Color fundus image
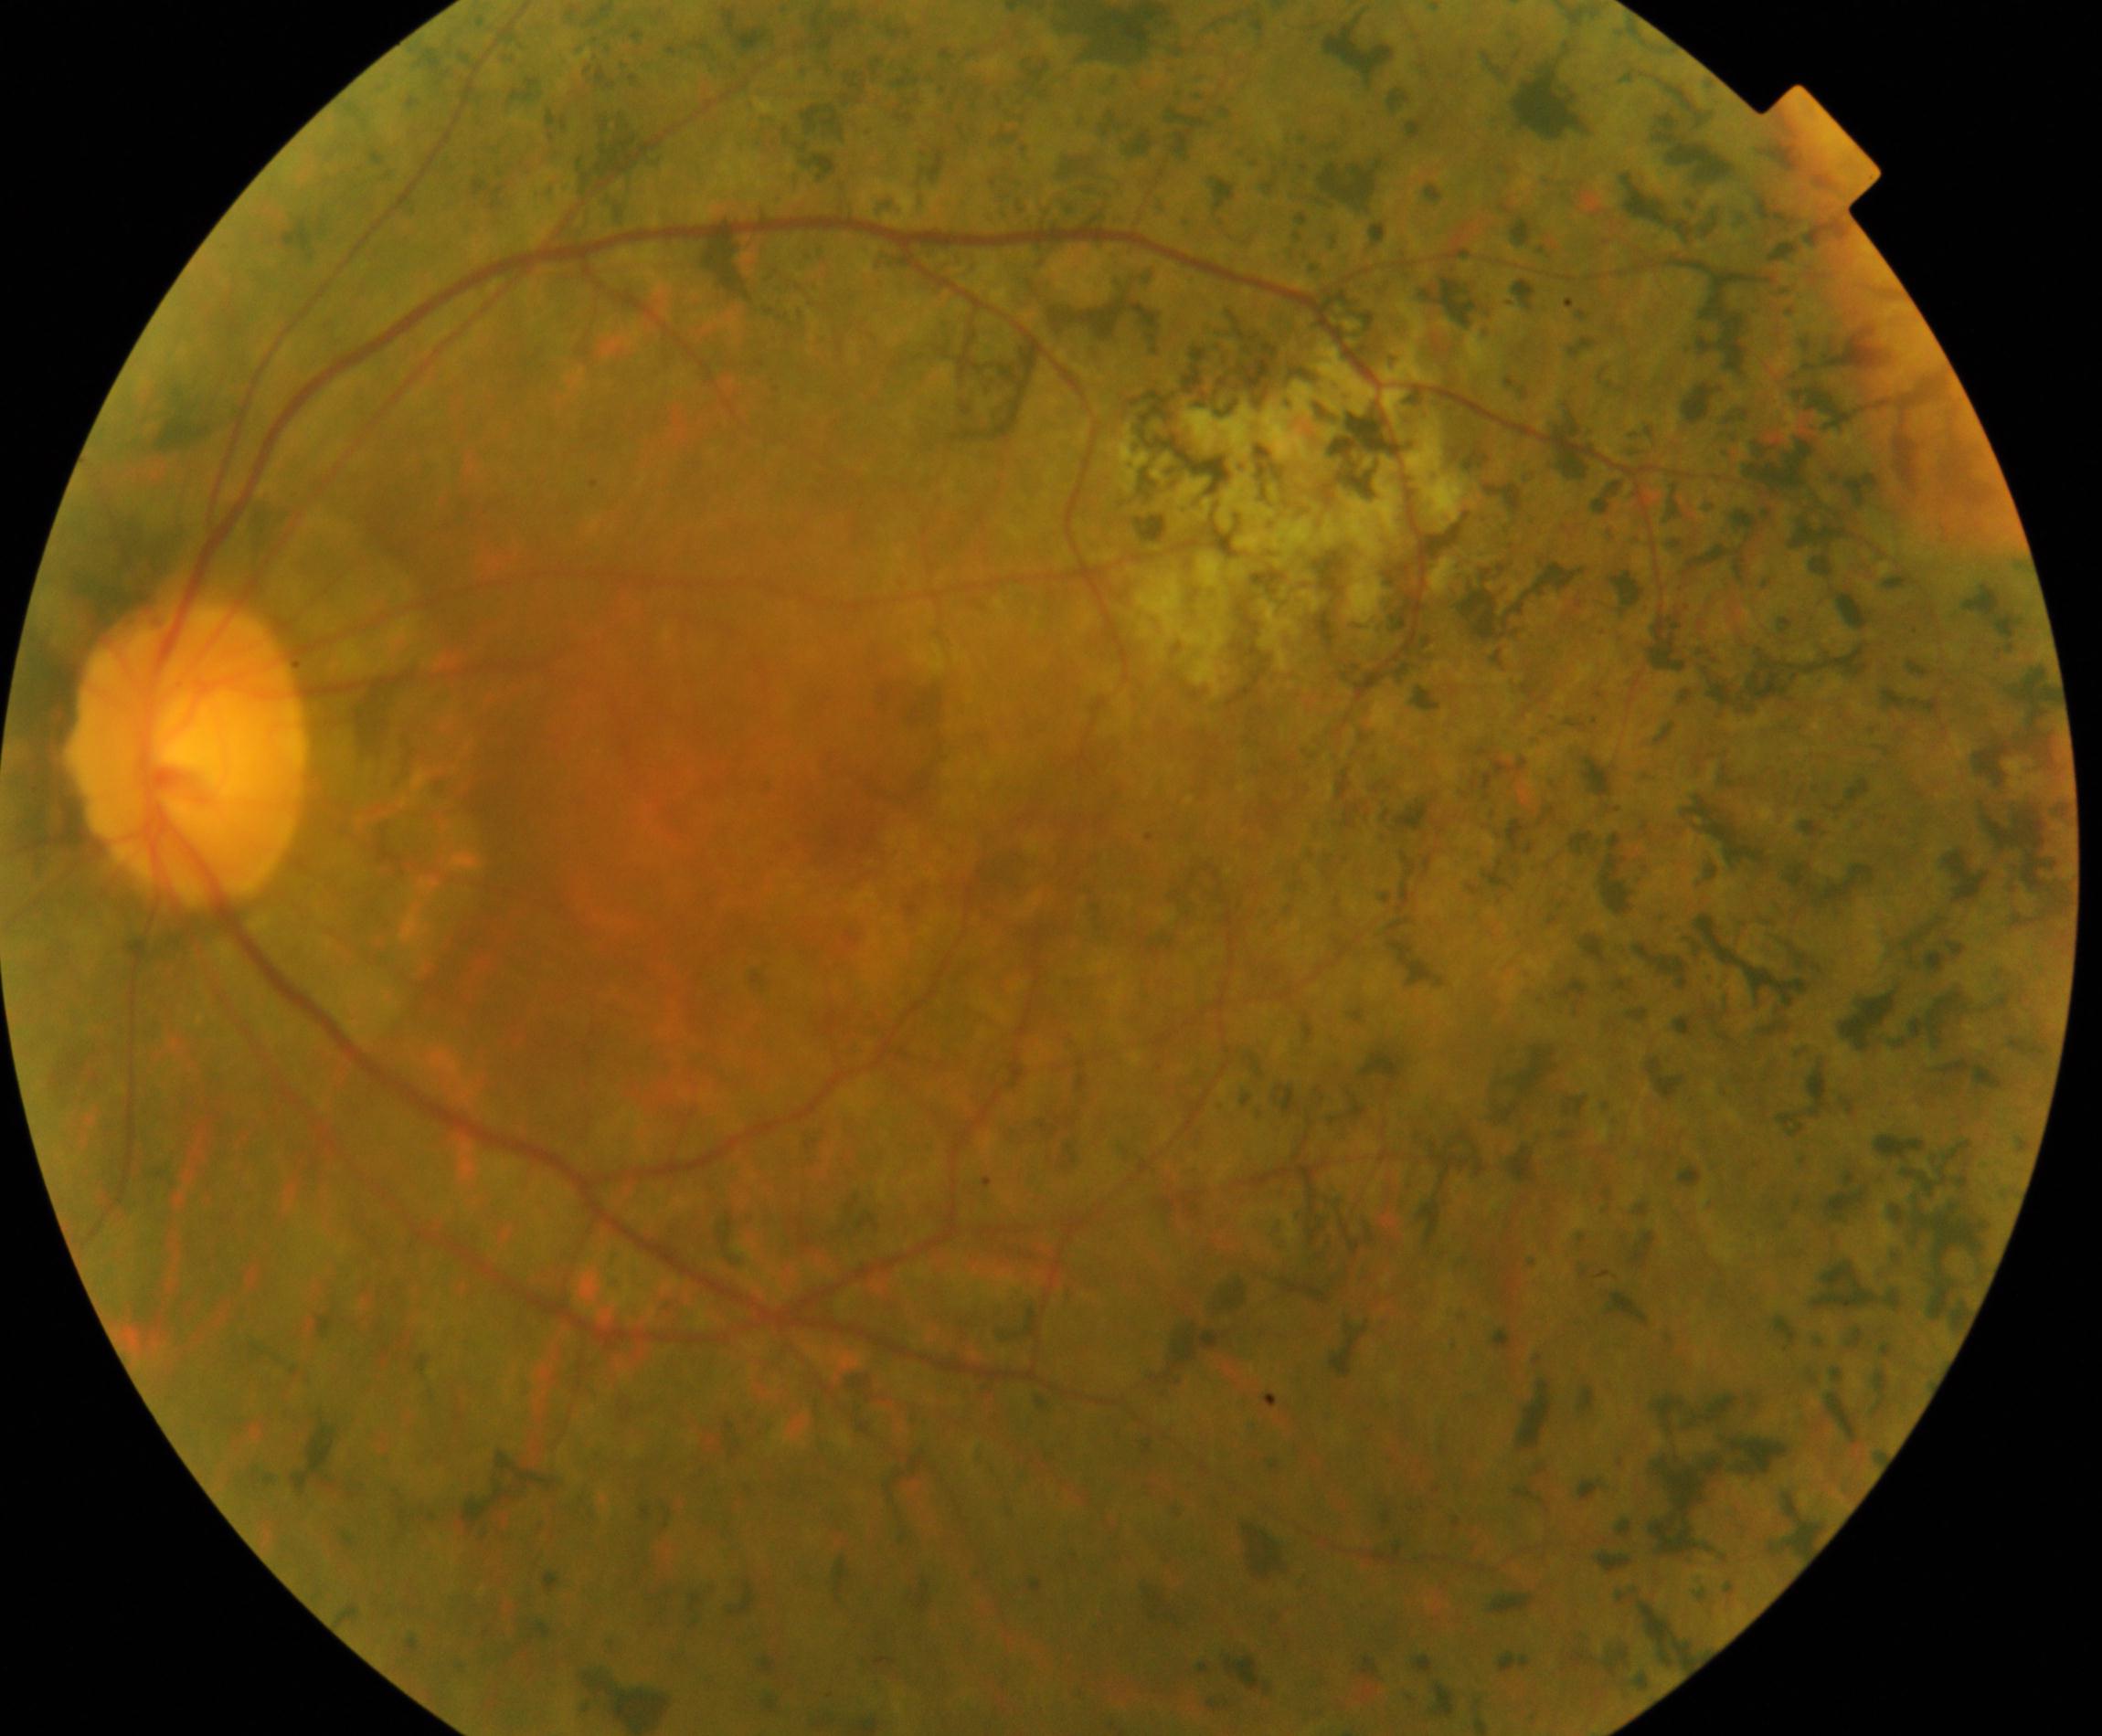 Impression: retinitis pigmentosa.